ONH-centered crop from a color fundus image — 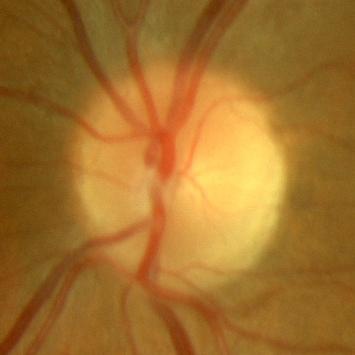

Finding = no glaucomatous changes.